Image size 2184x1691. Color fundus image — 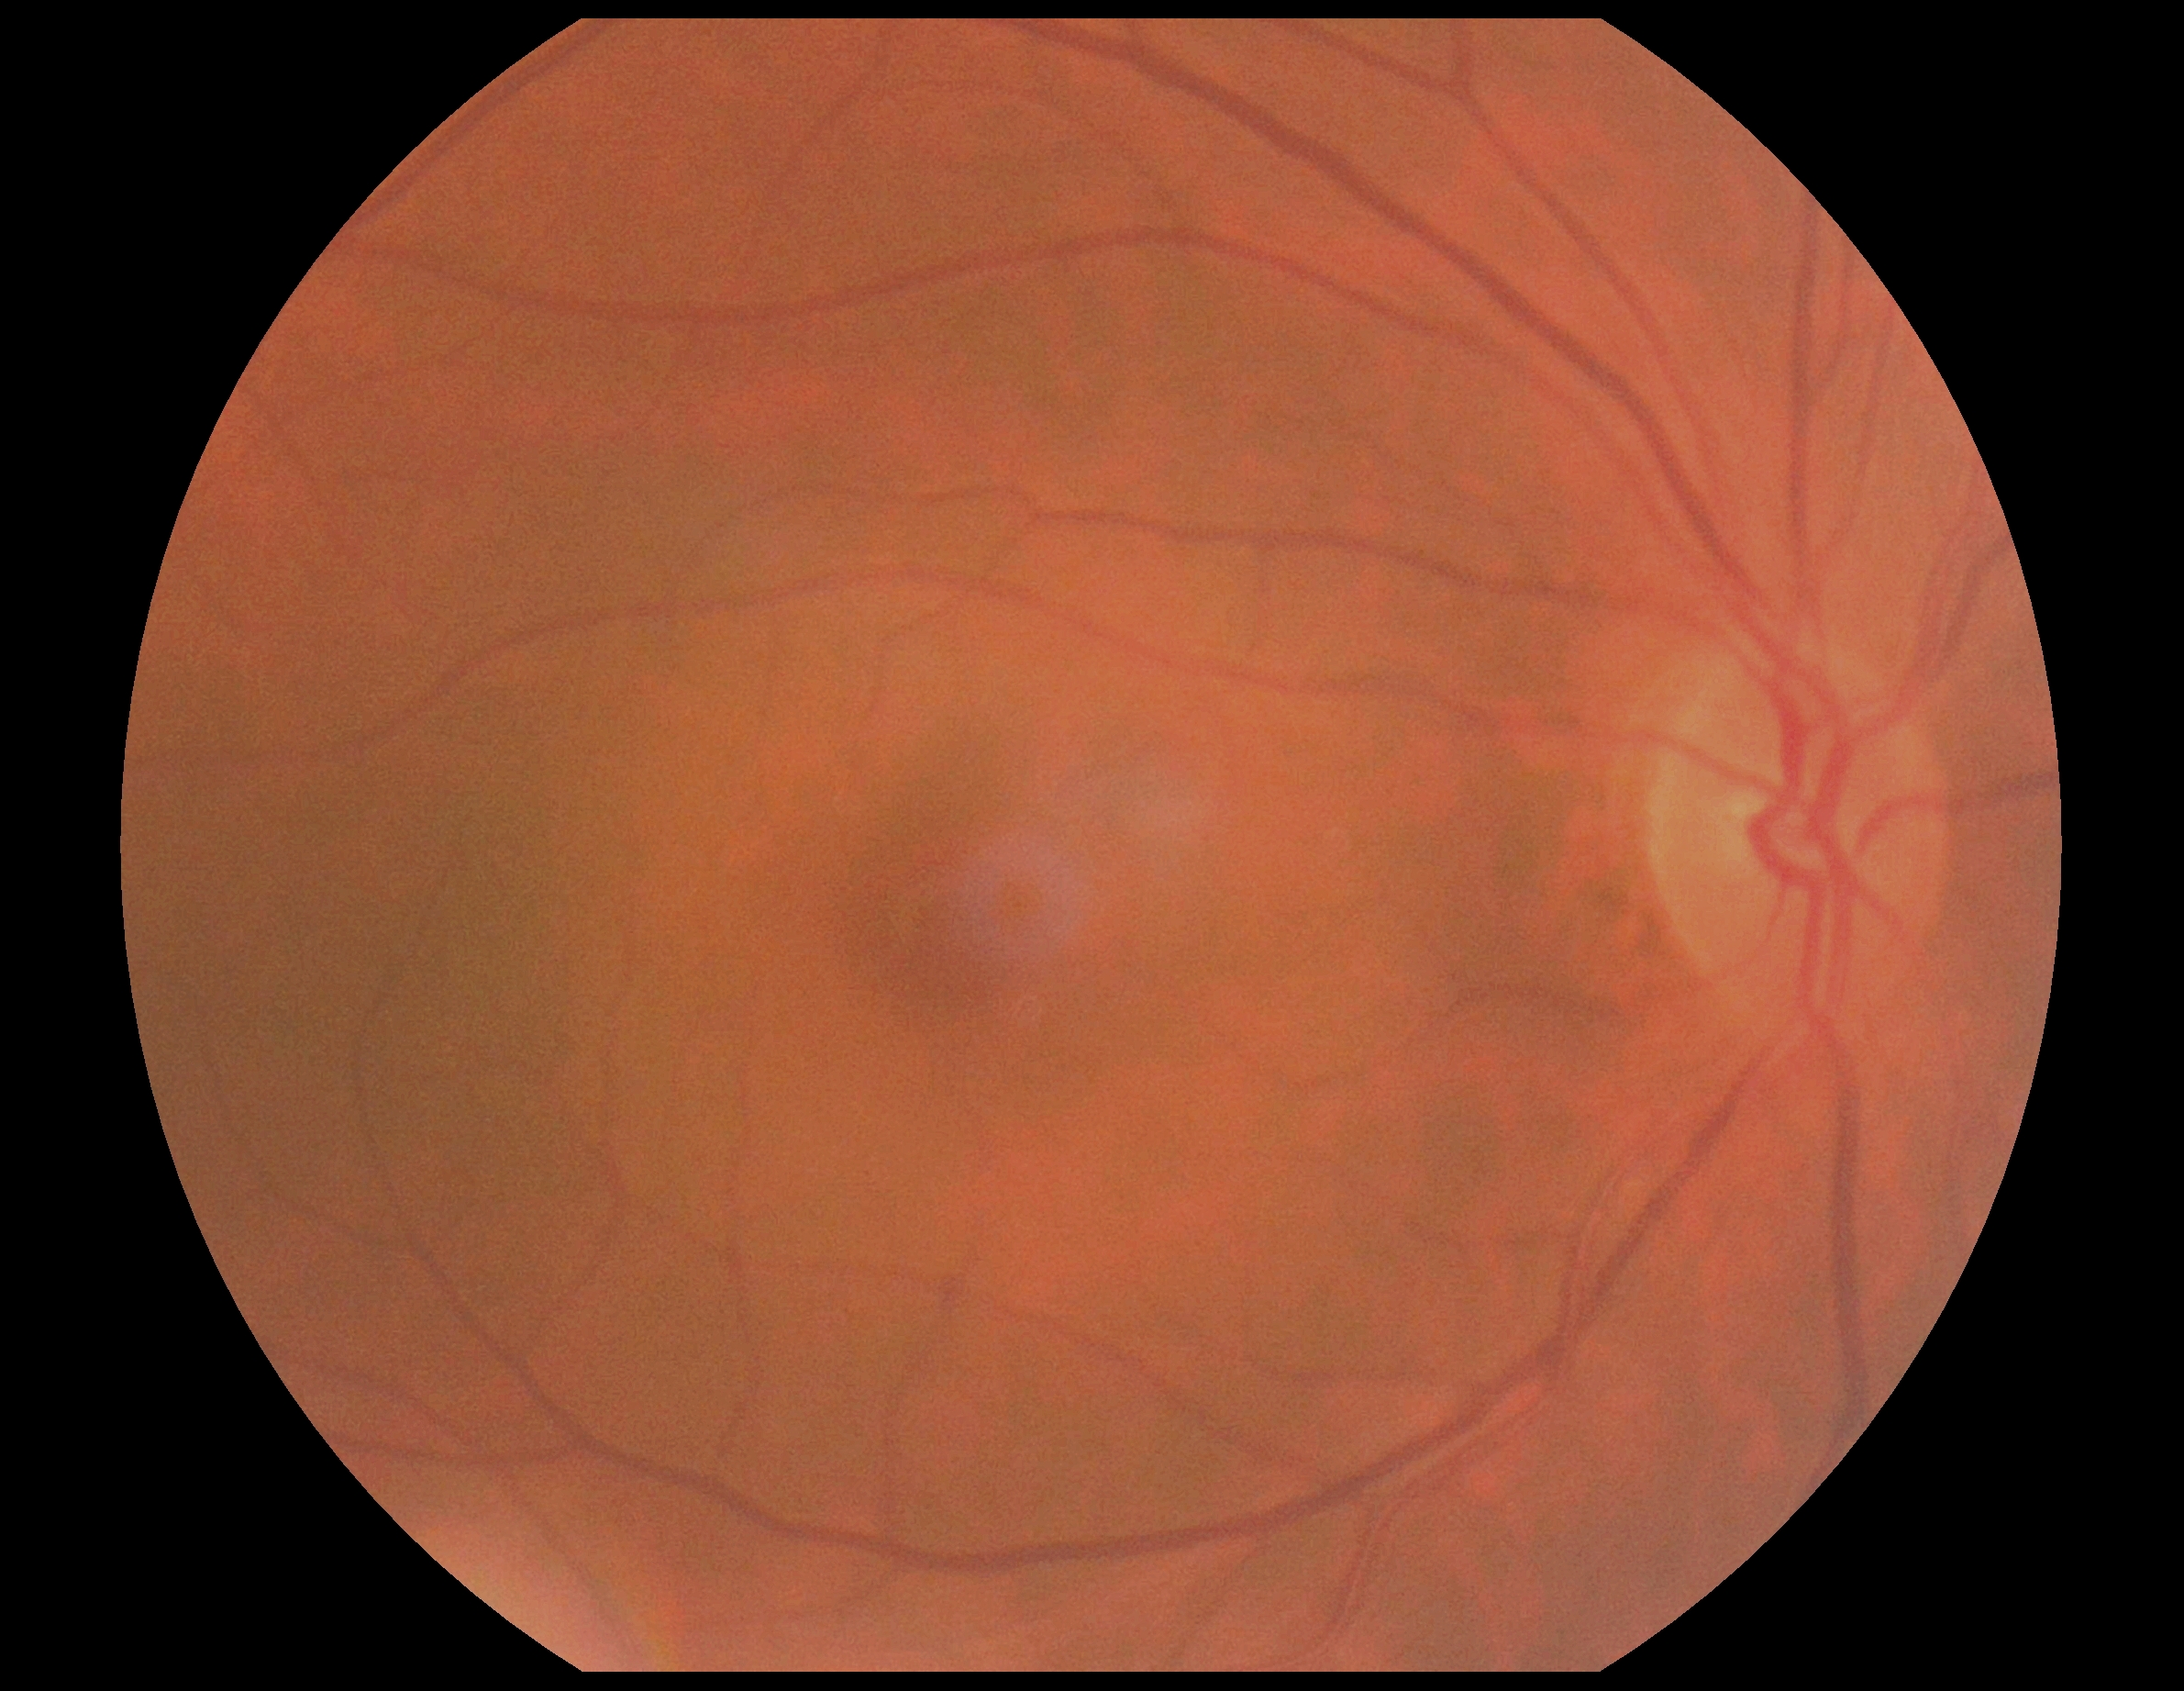 DR severity: grade 0 (no apparent retinopathy).